1240 by 1240 pixels · pediatric retinal photograph (wide-field) · acquired on the Phoenix ICON — 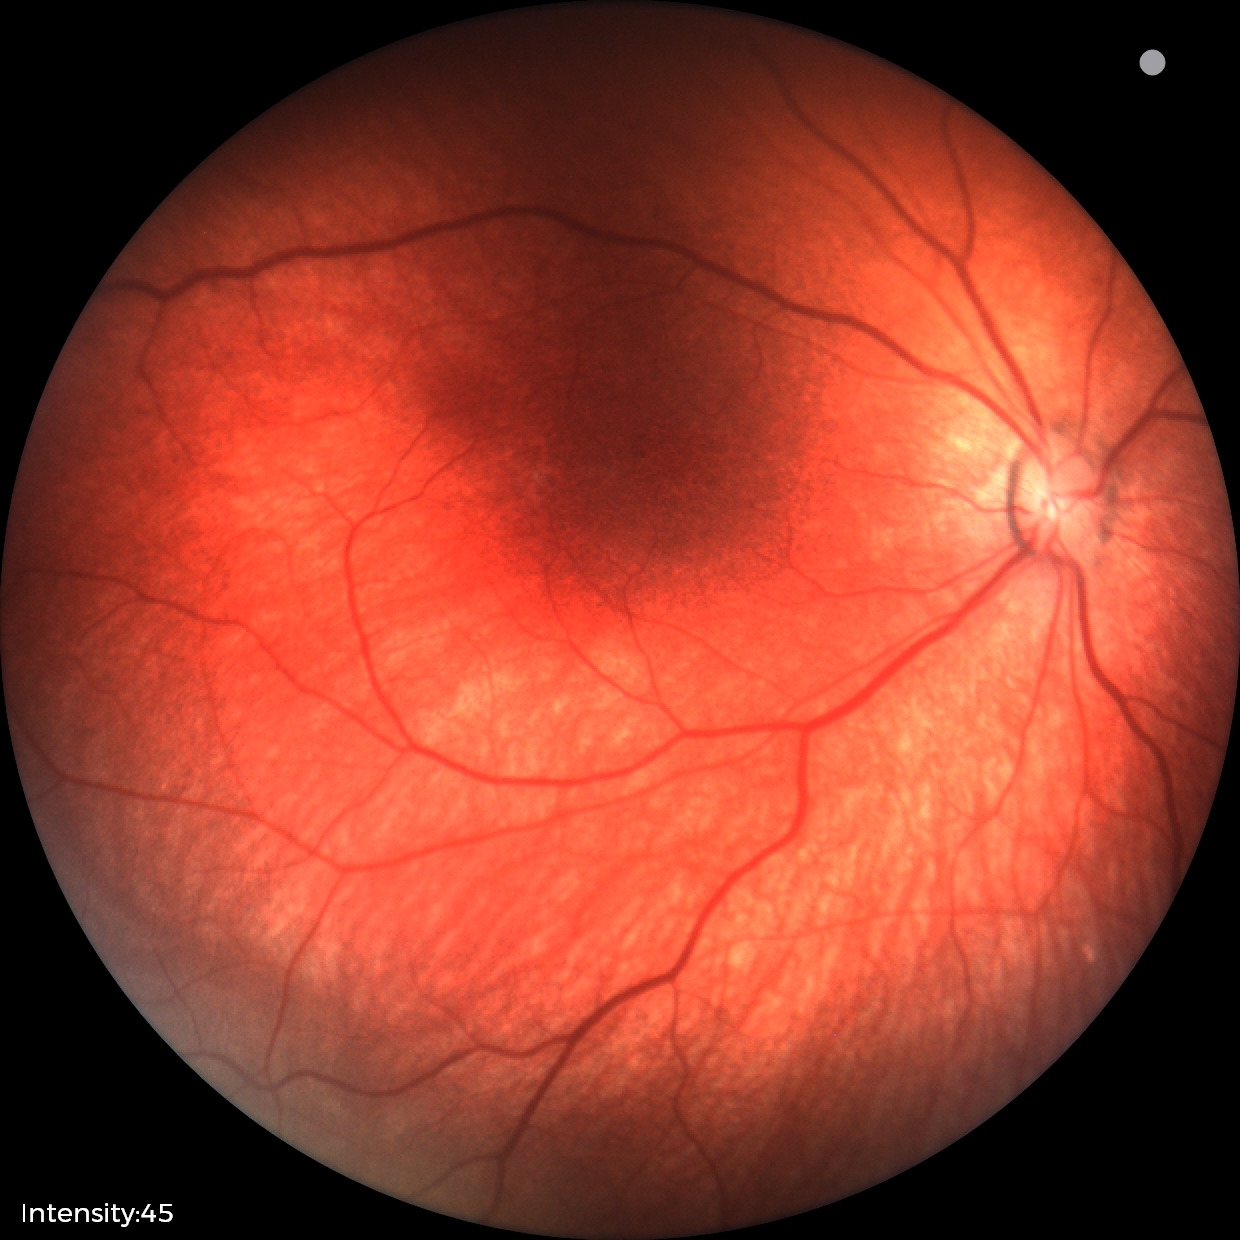
No retinal pathology identified on screening.